Fundus photo:
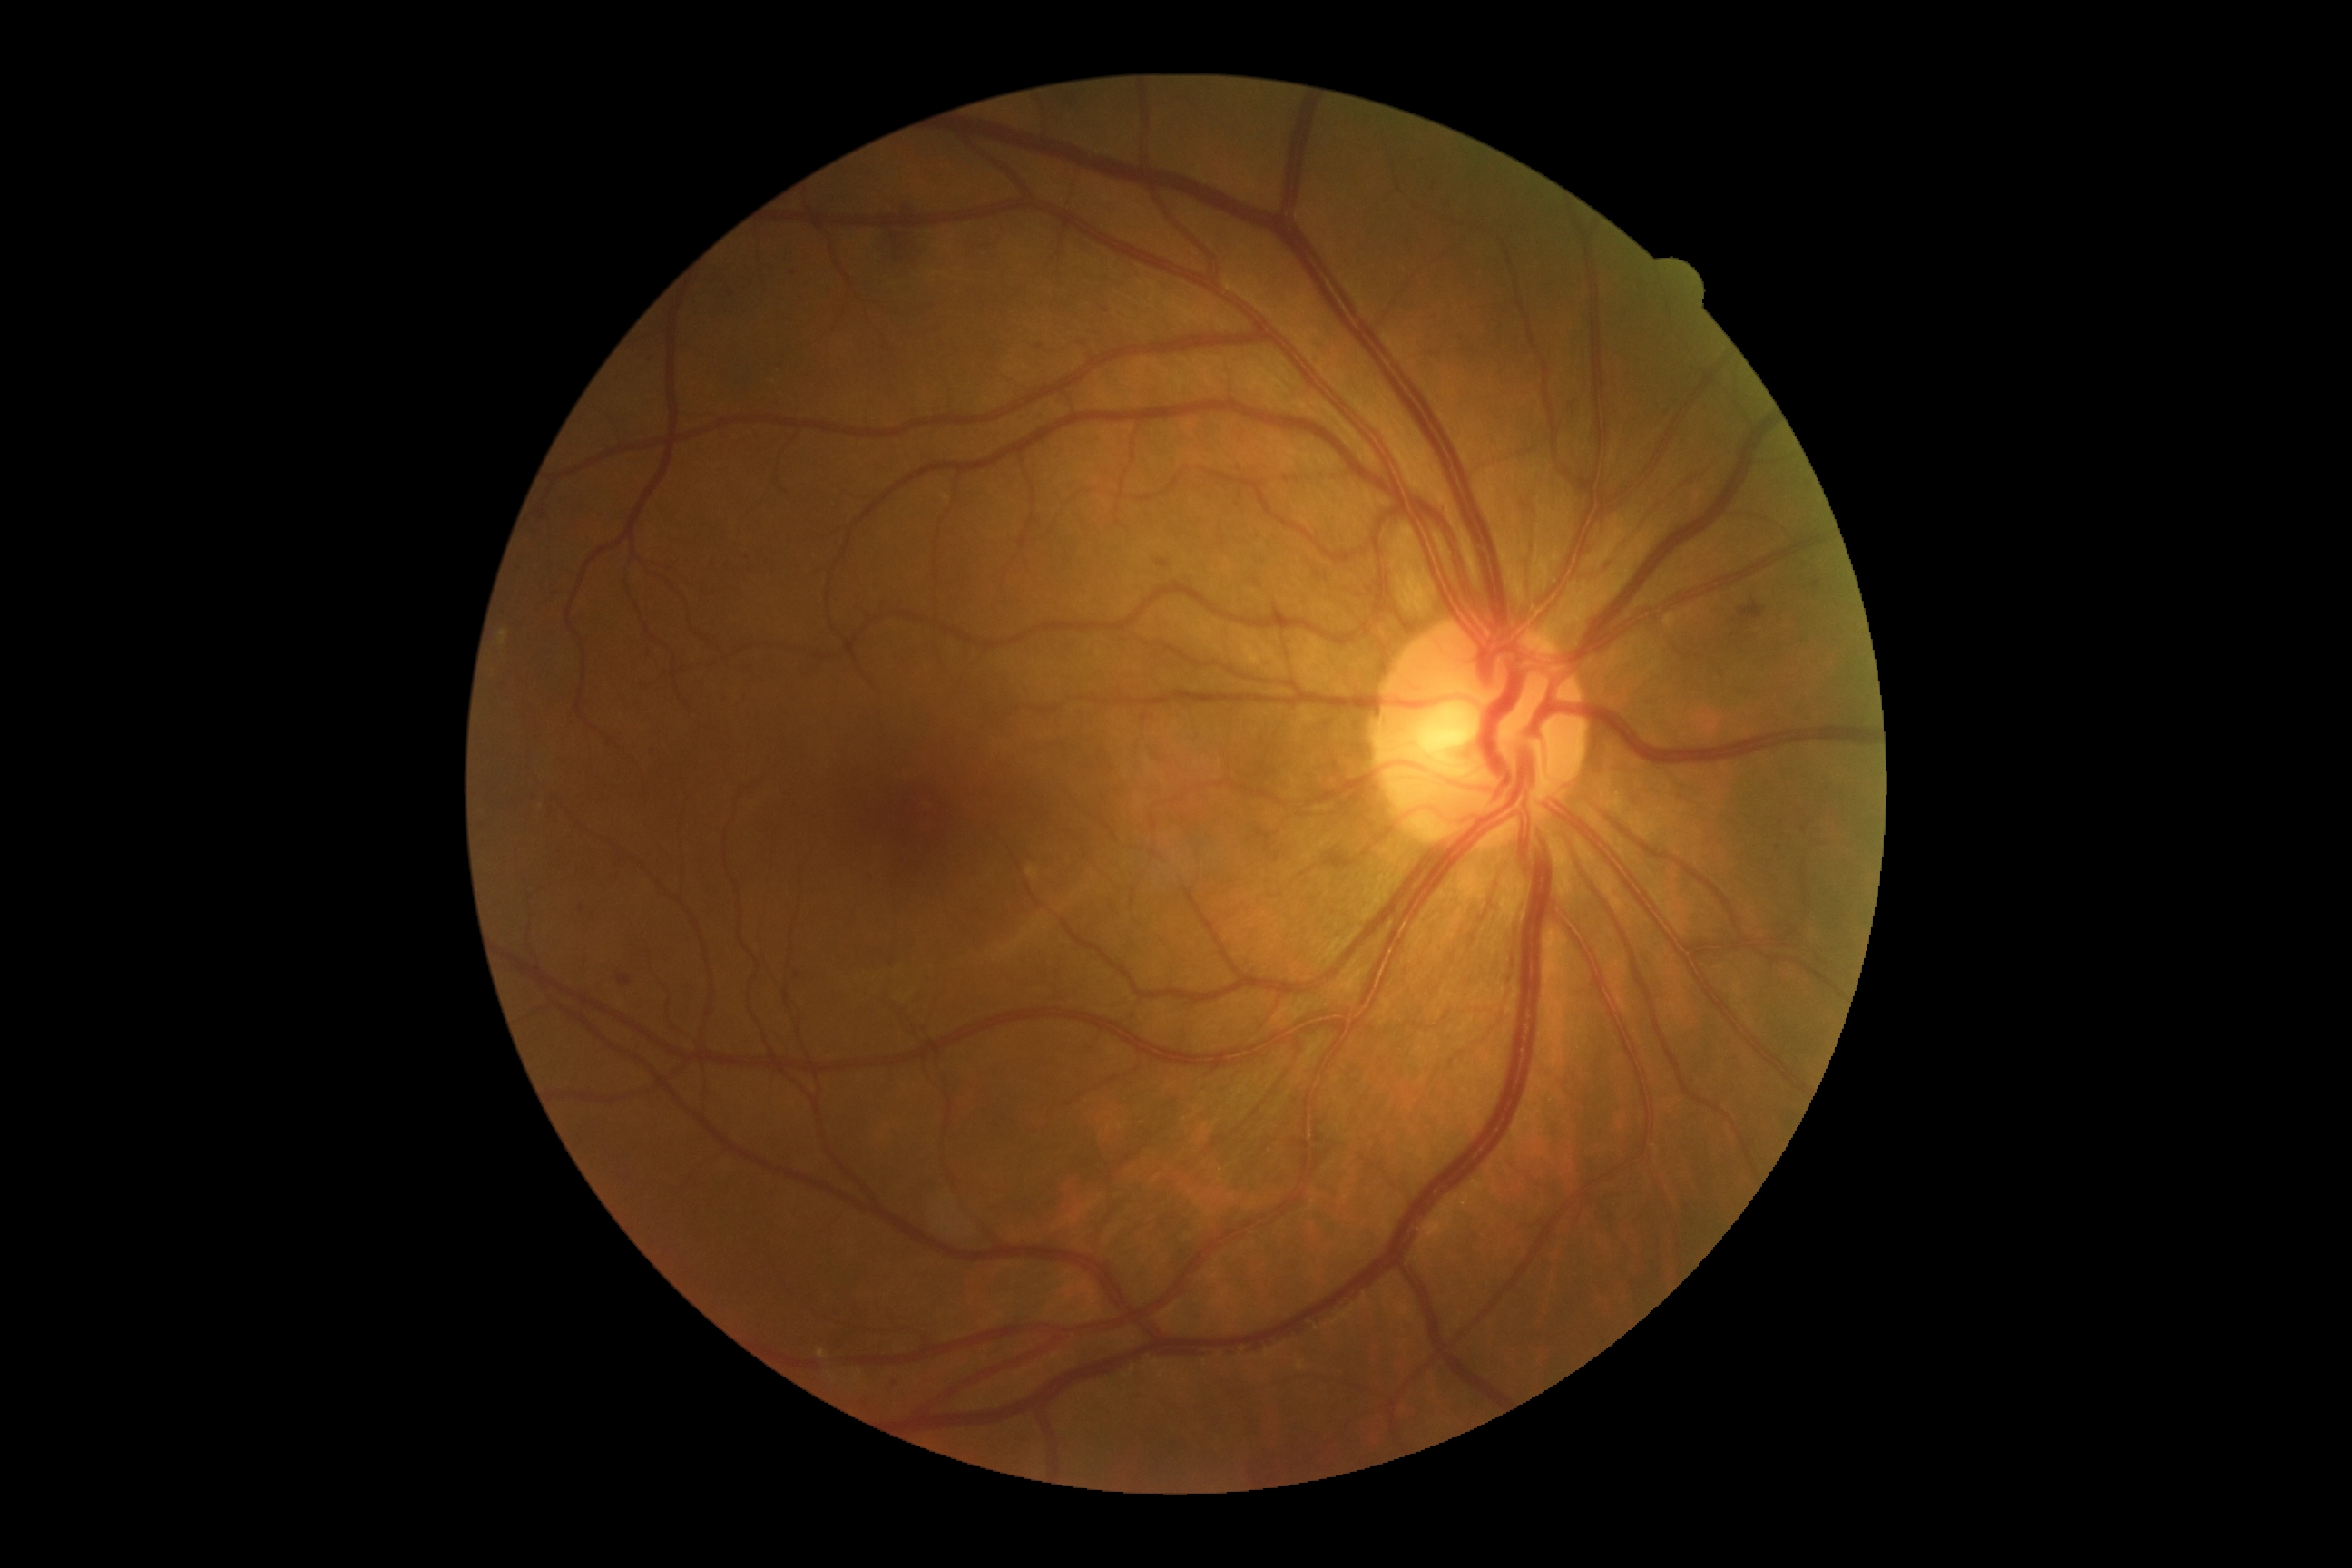

{
  "dr_grade": "grade 2 (moderate NPDR)"
}